Image size 240x240, cropped to the optic nerve head, acquired with a Nidek AFC-330.
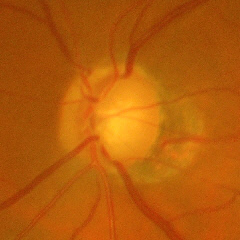 Fundus image with findings of severe glaucomatous damage.